Color fundus image
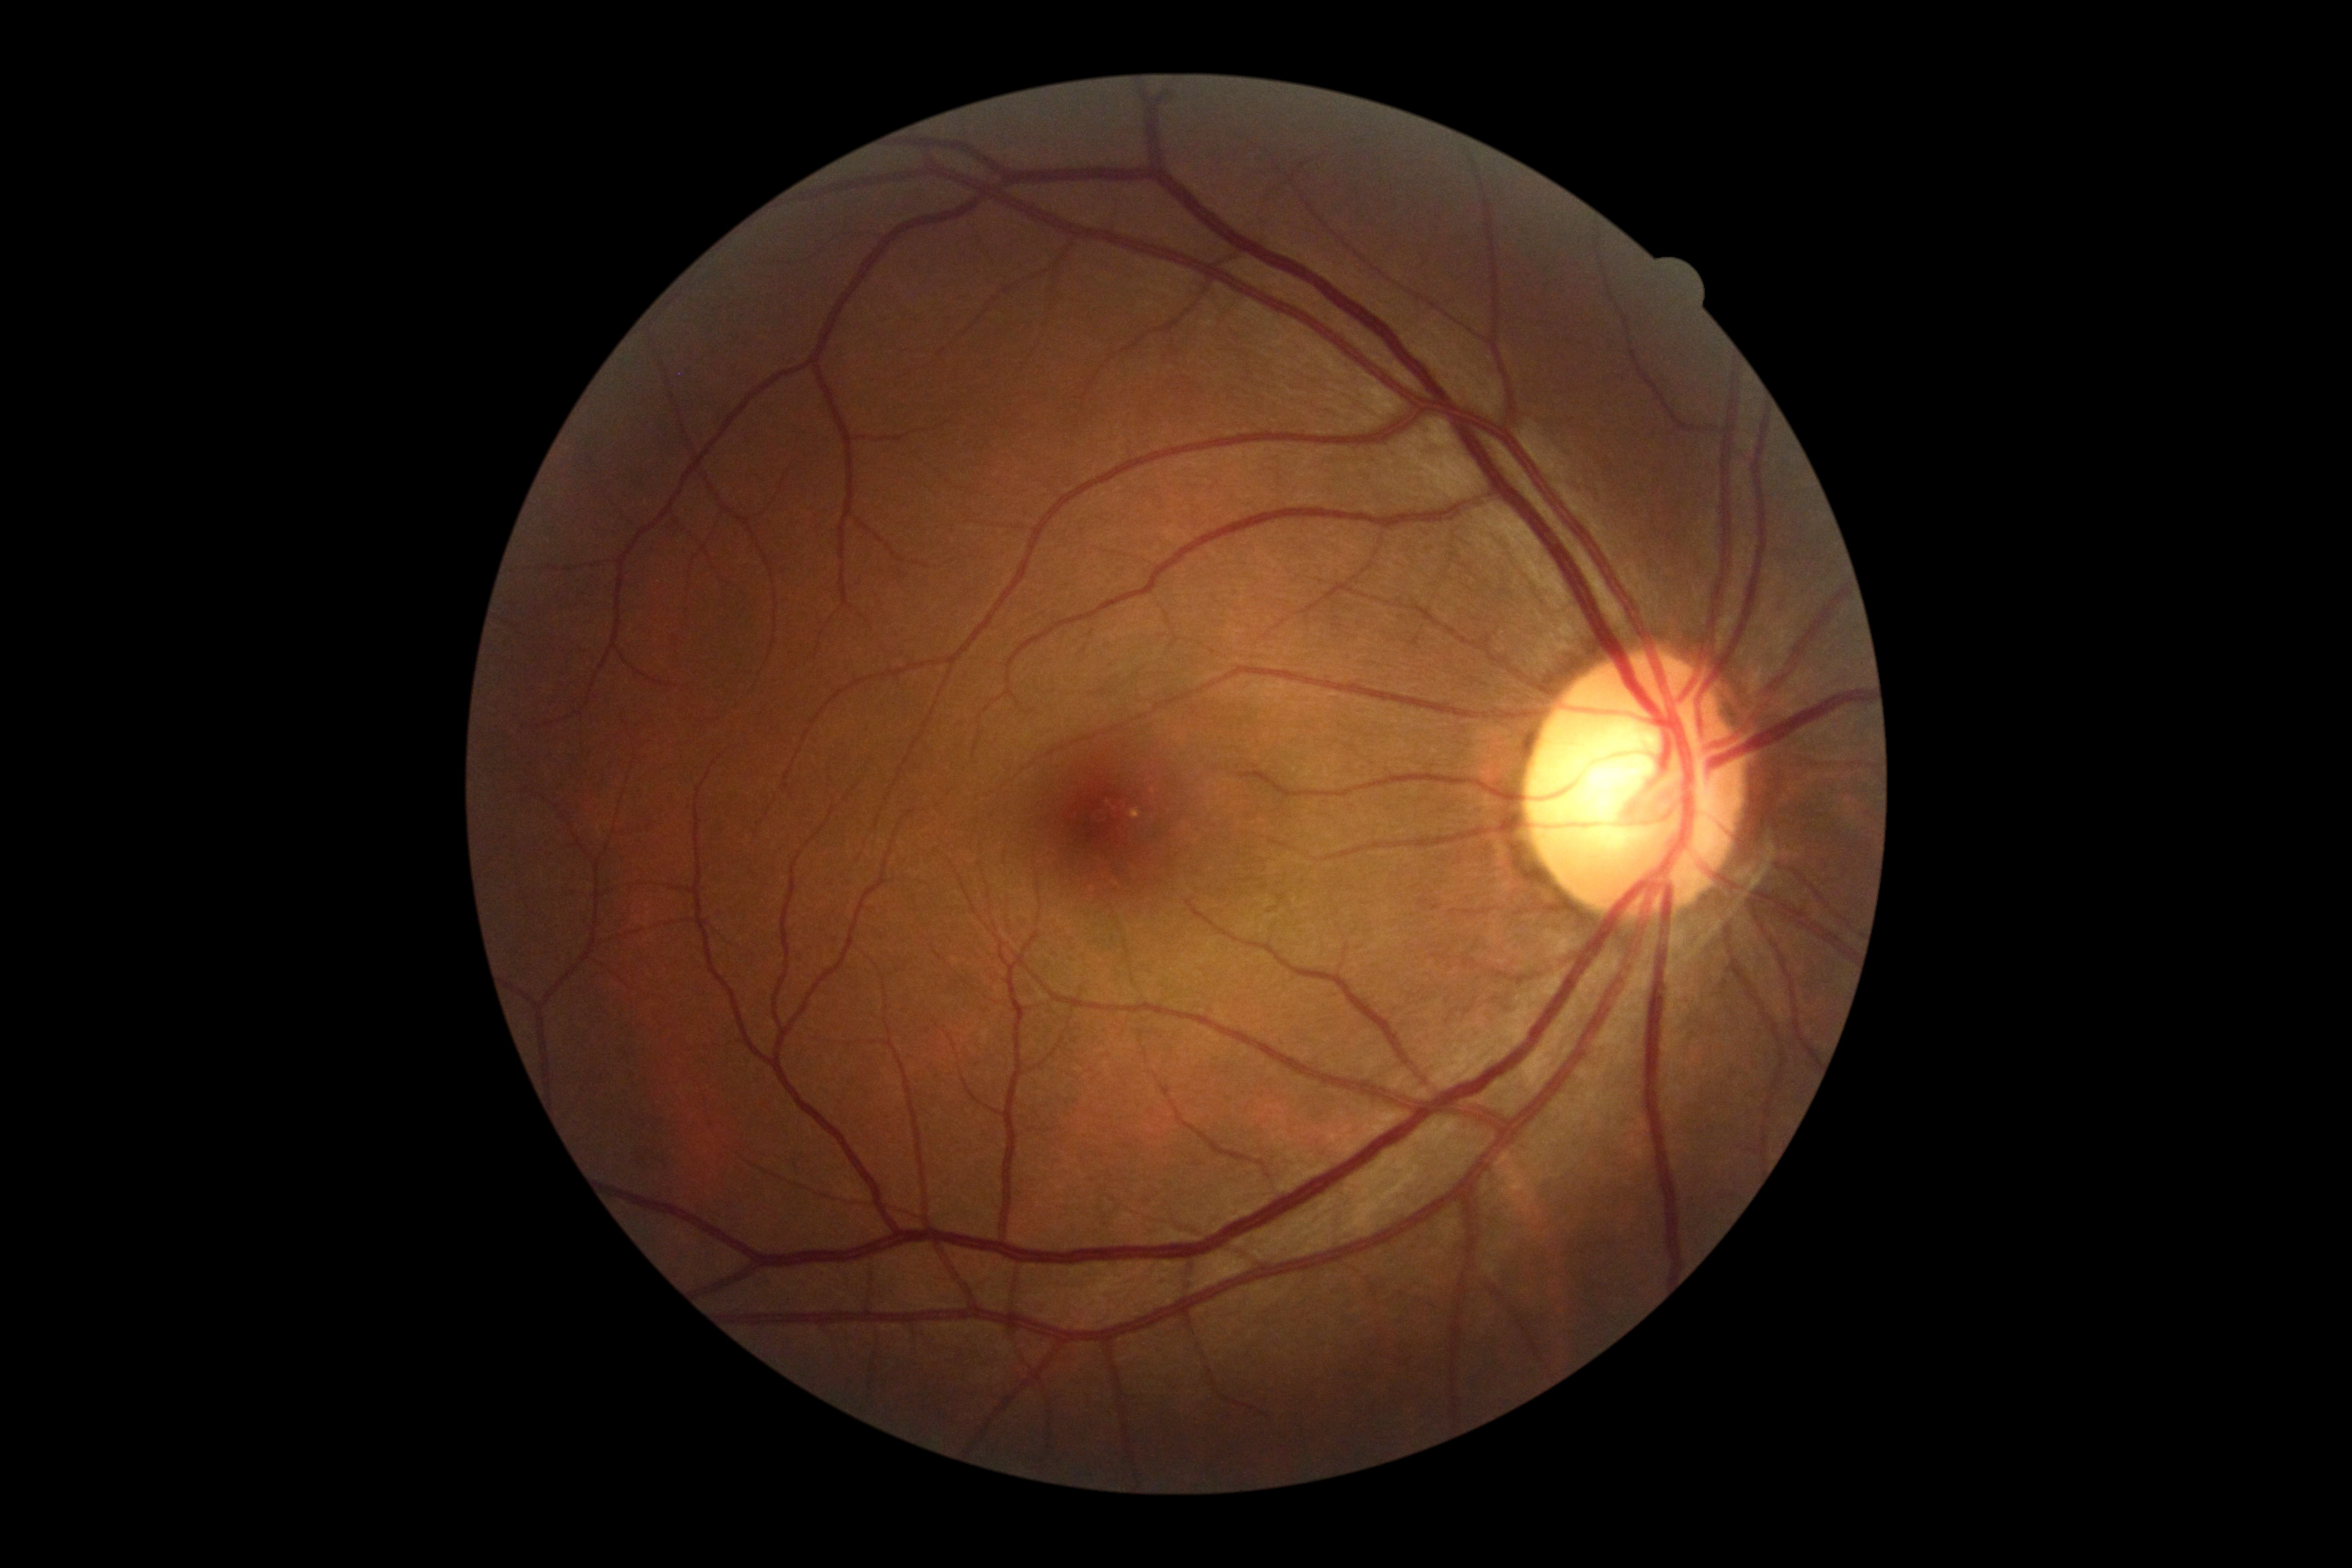

Diabetic retinopathy (DR) is no apparent retinopathy (grade 0).